Fundus photo, image size 848x848, 45-degree field of view, modified Davis classification: 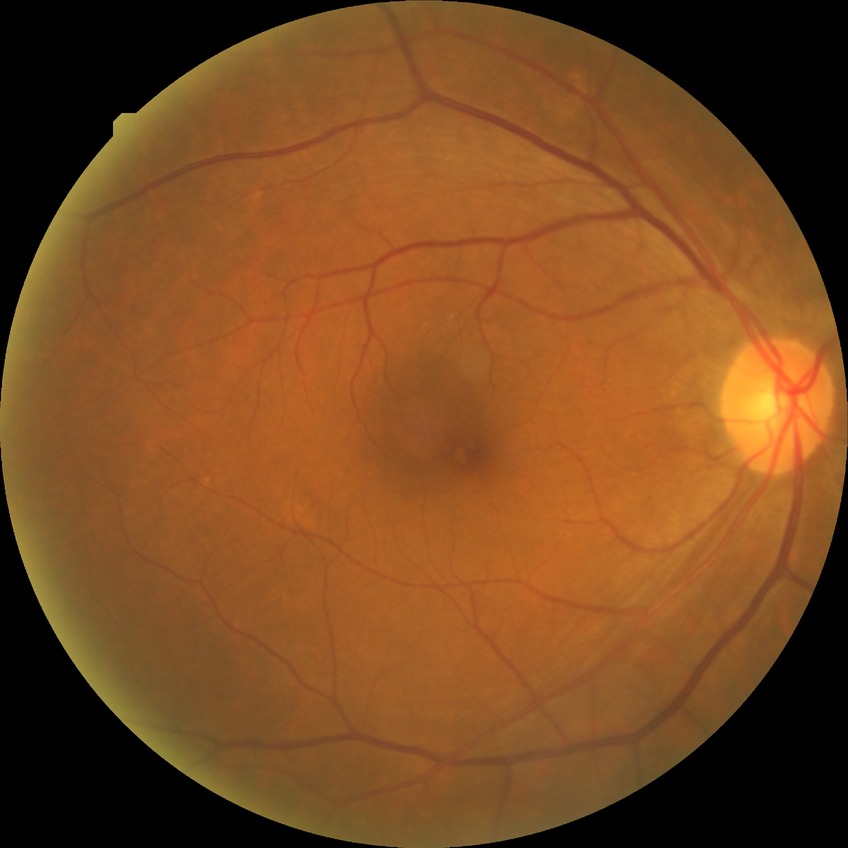

diabetic retinopathy (DR)@NDR (no diabetic retinopathy).